CFP.
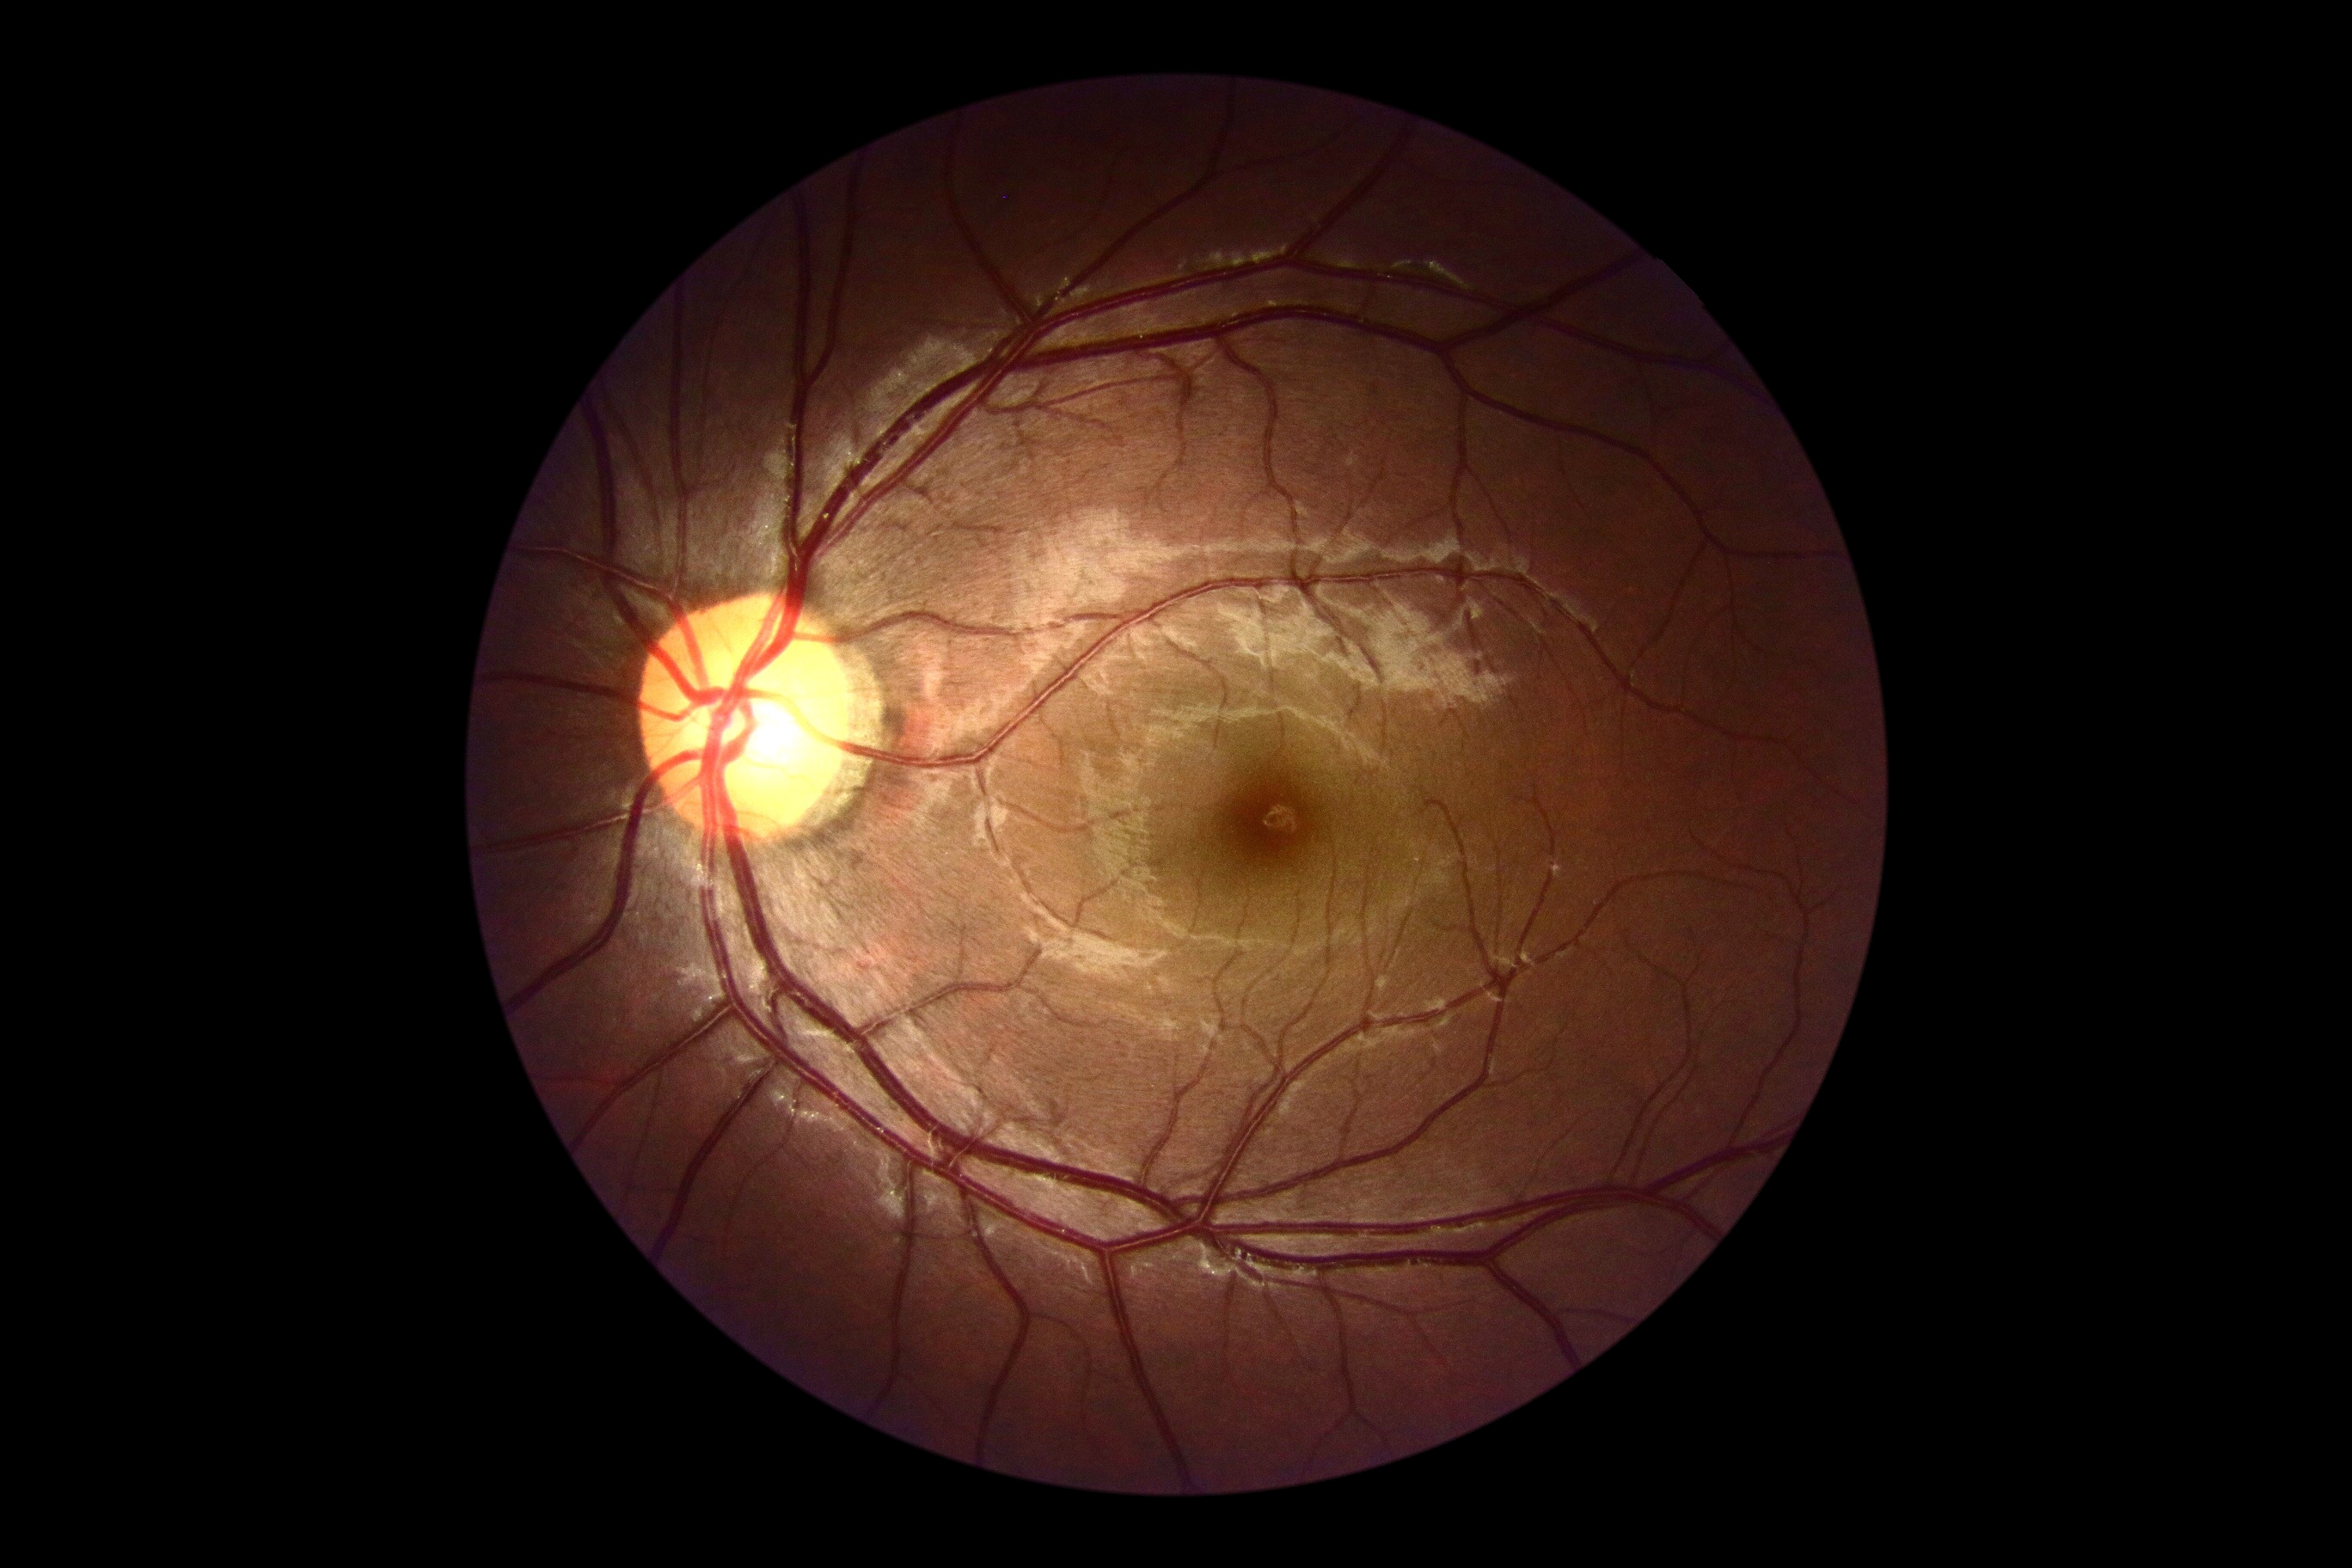
diabetic retinopathy = grade 0 (no apparent retinopathy).